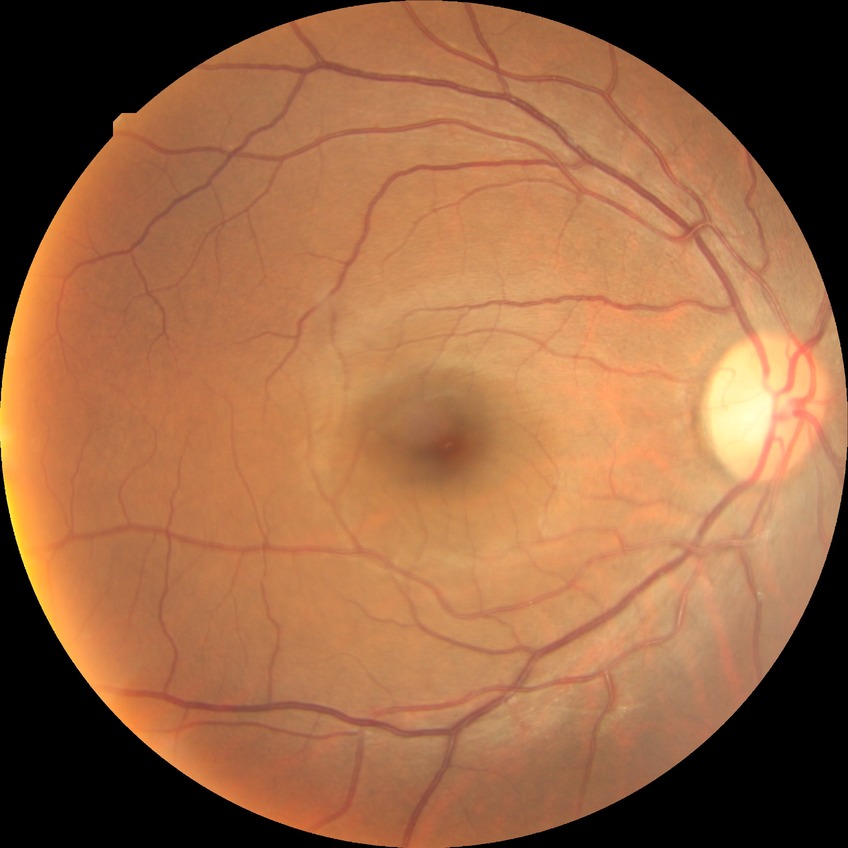

DR grade: NDR
DR impression: no DR findings